1444x1444px · 45° FOV · retinal fundus photograph:
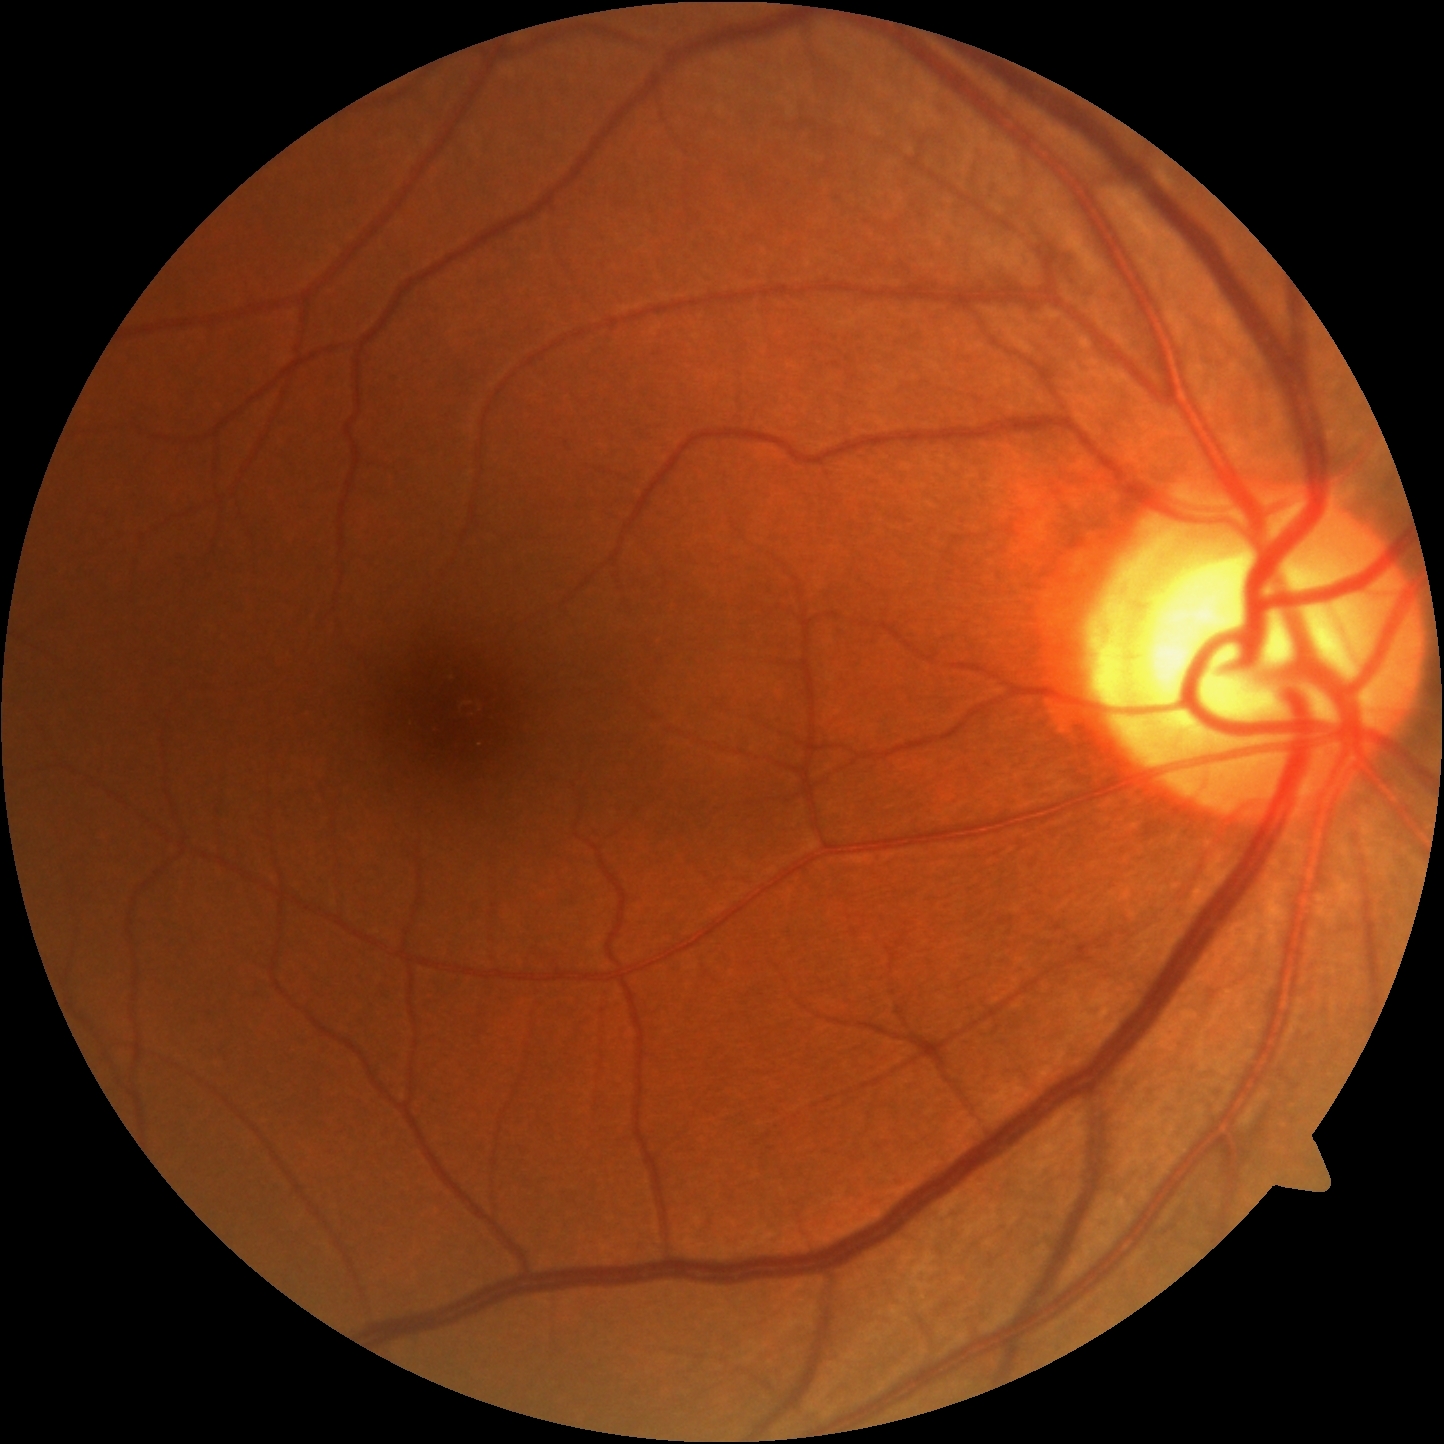 Retinopathy grade: 0/4 — no visible signs of diabetic retinopathy. No apparent diabetic retinopathy.